Retinal fundus photograph, 2352 x 1568 pixels, 45° FOV:
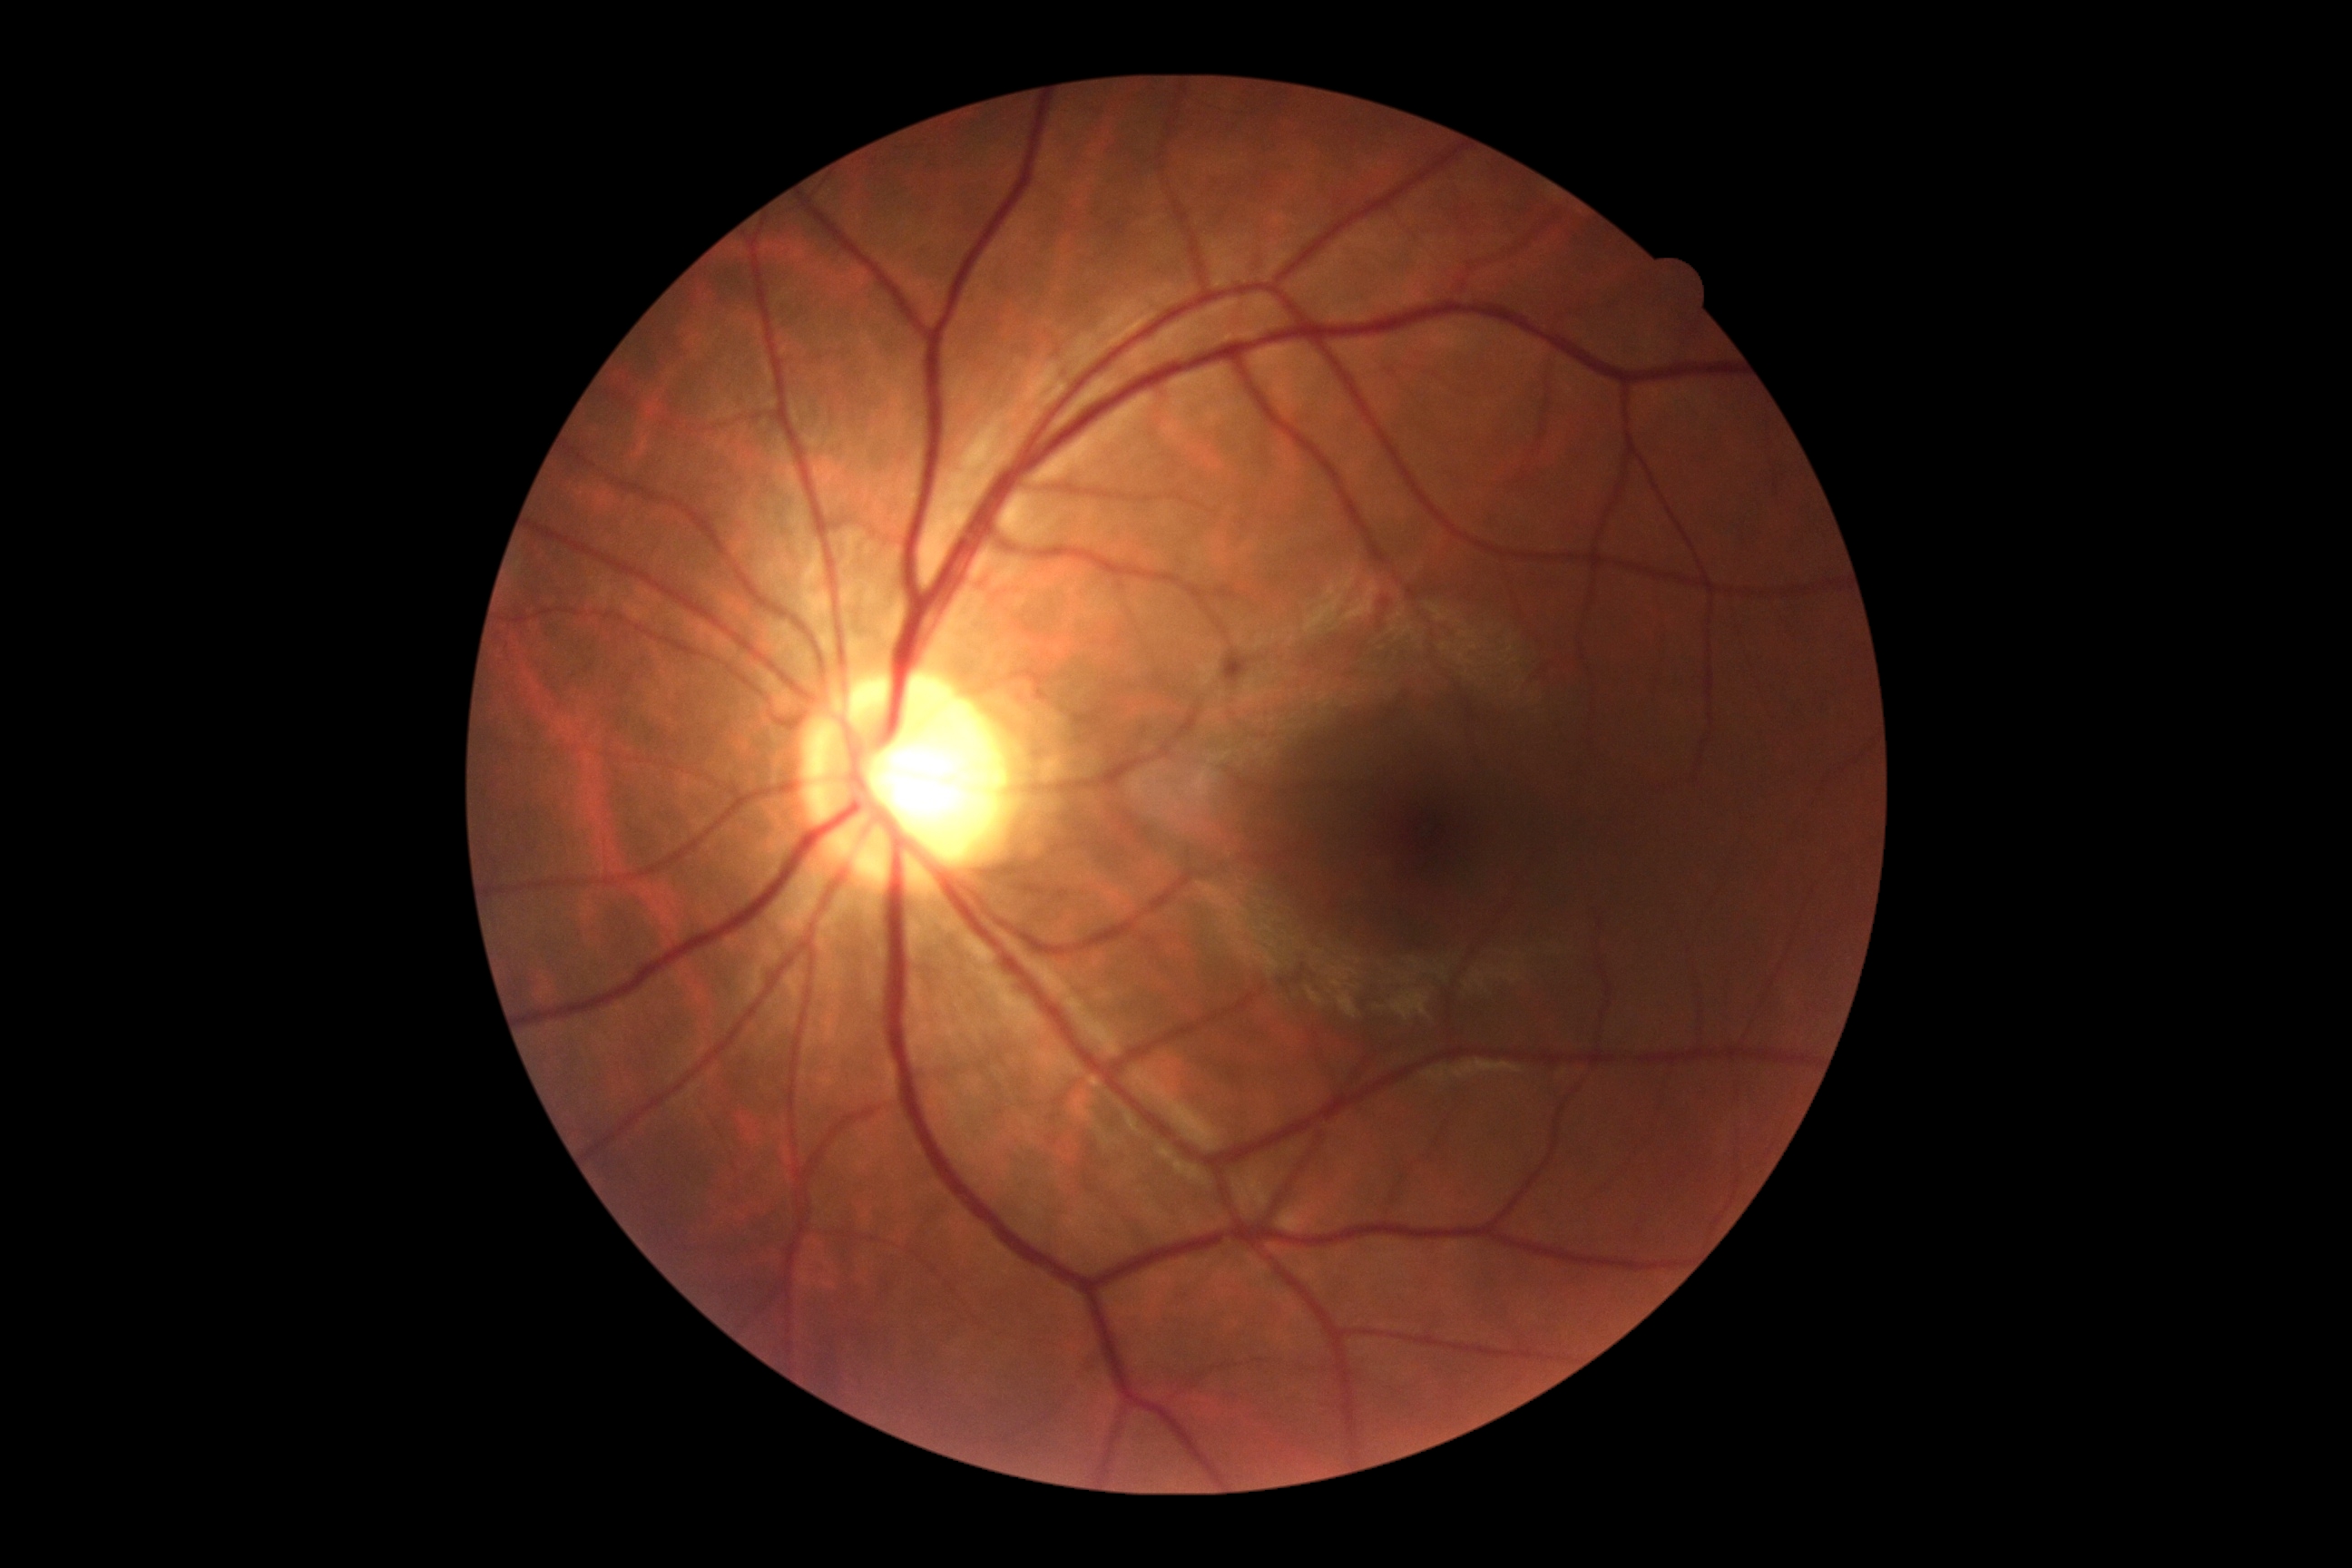 Findings:
* diabetic retinopathy (DR): no apparent diabetic retinopathy (grade 0) — no visible signs of diabetic retinopathy